Wide-field fundus photograph from neonatal ROP screening; acquired on the Clarity RetCam 3; 640x480:
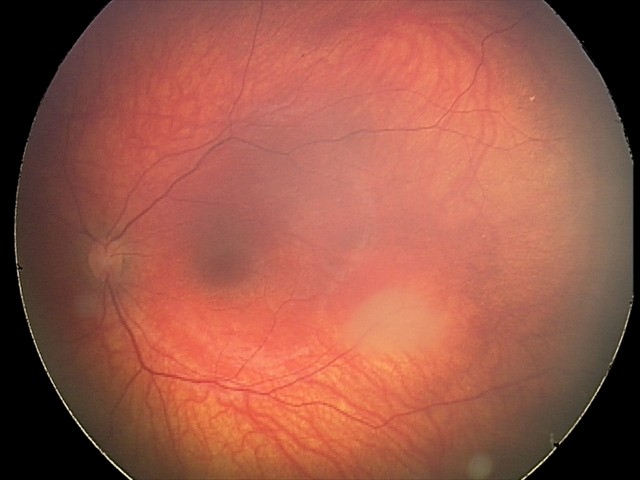
From an examination with diagnosis of retinal astrocytic hamartoma.